FOV: 45 degrees. Color fundus image. 2352x1568 — 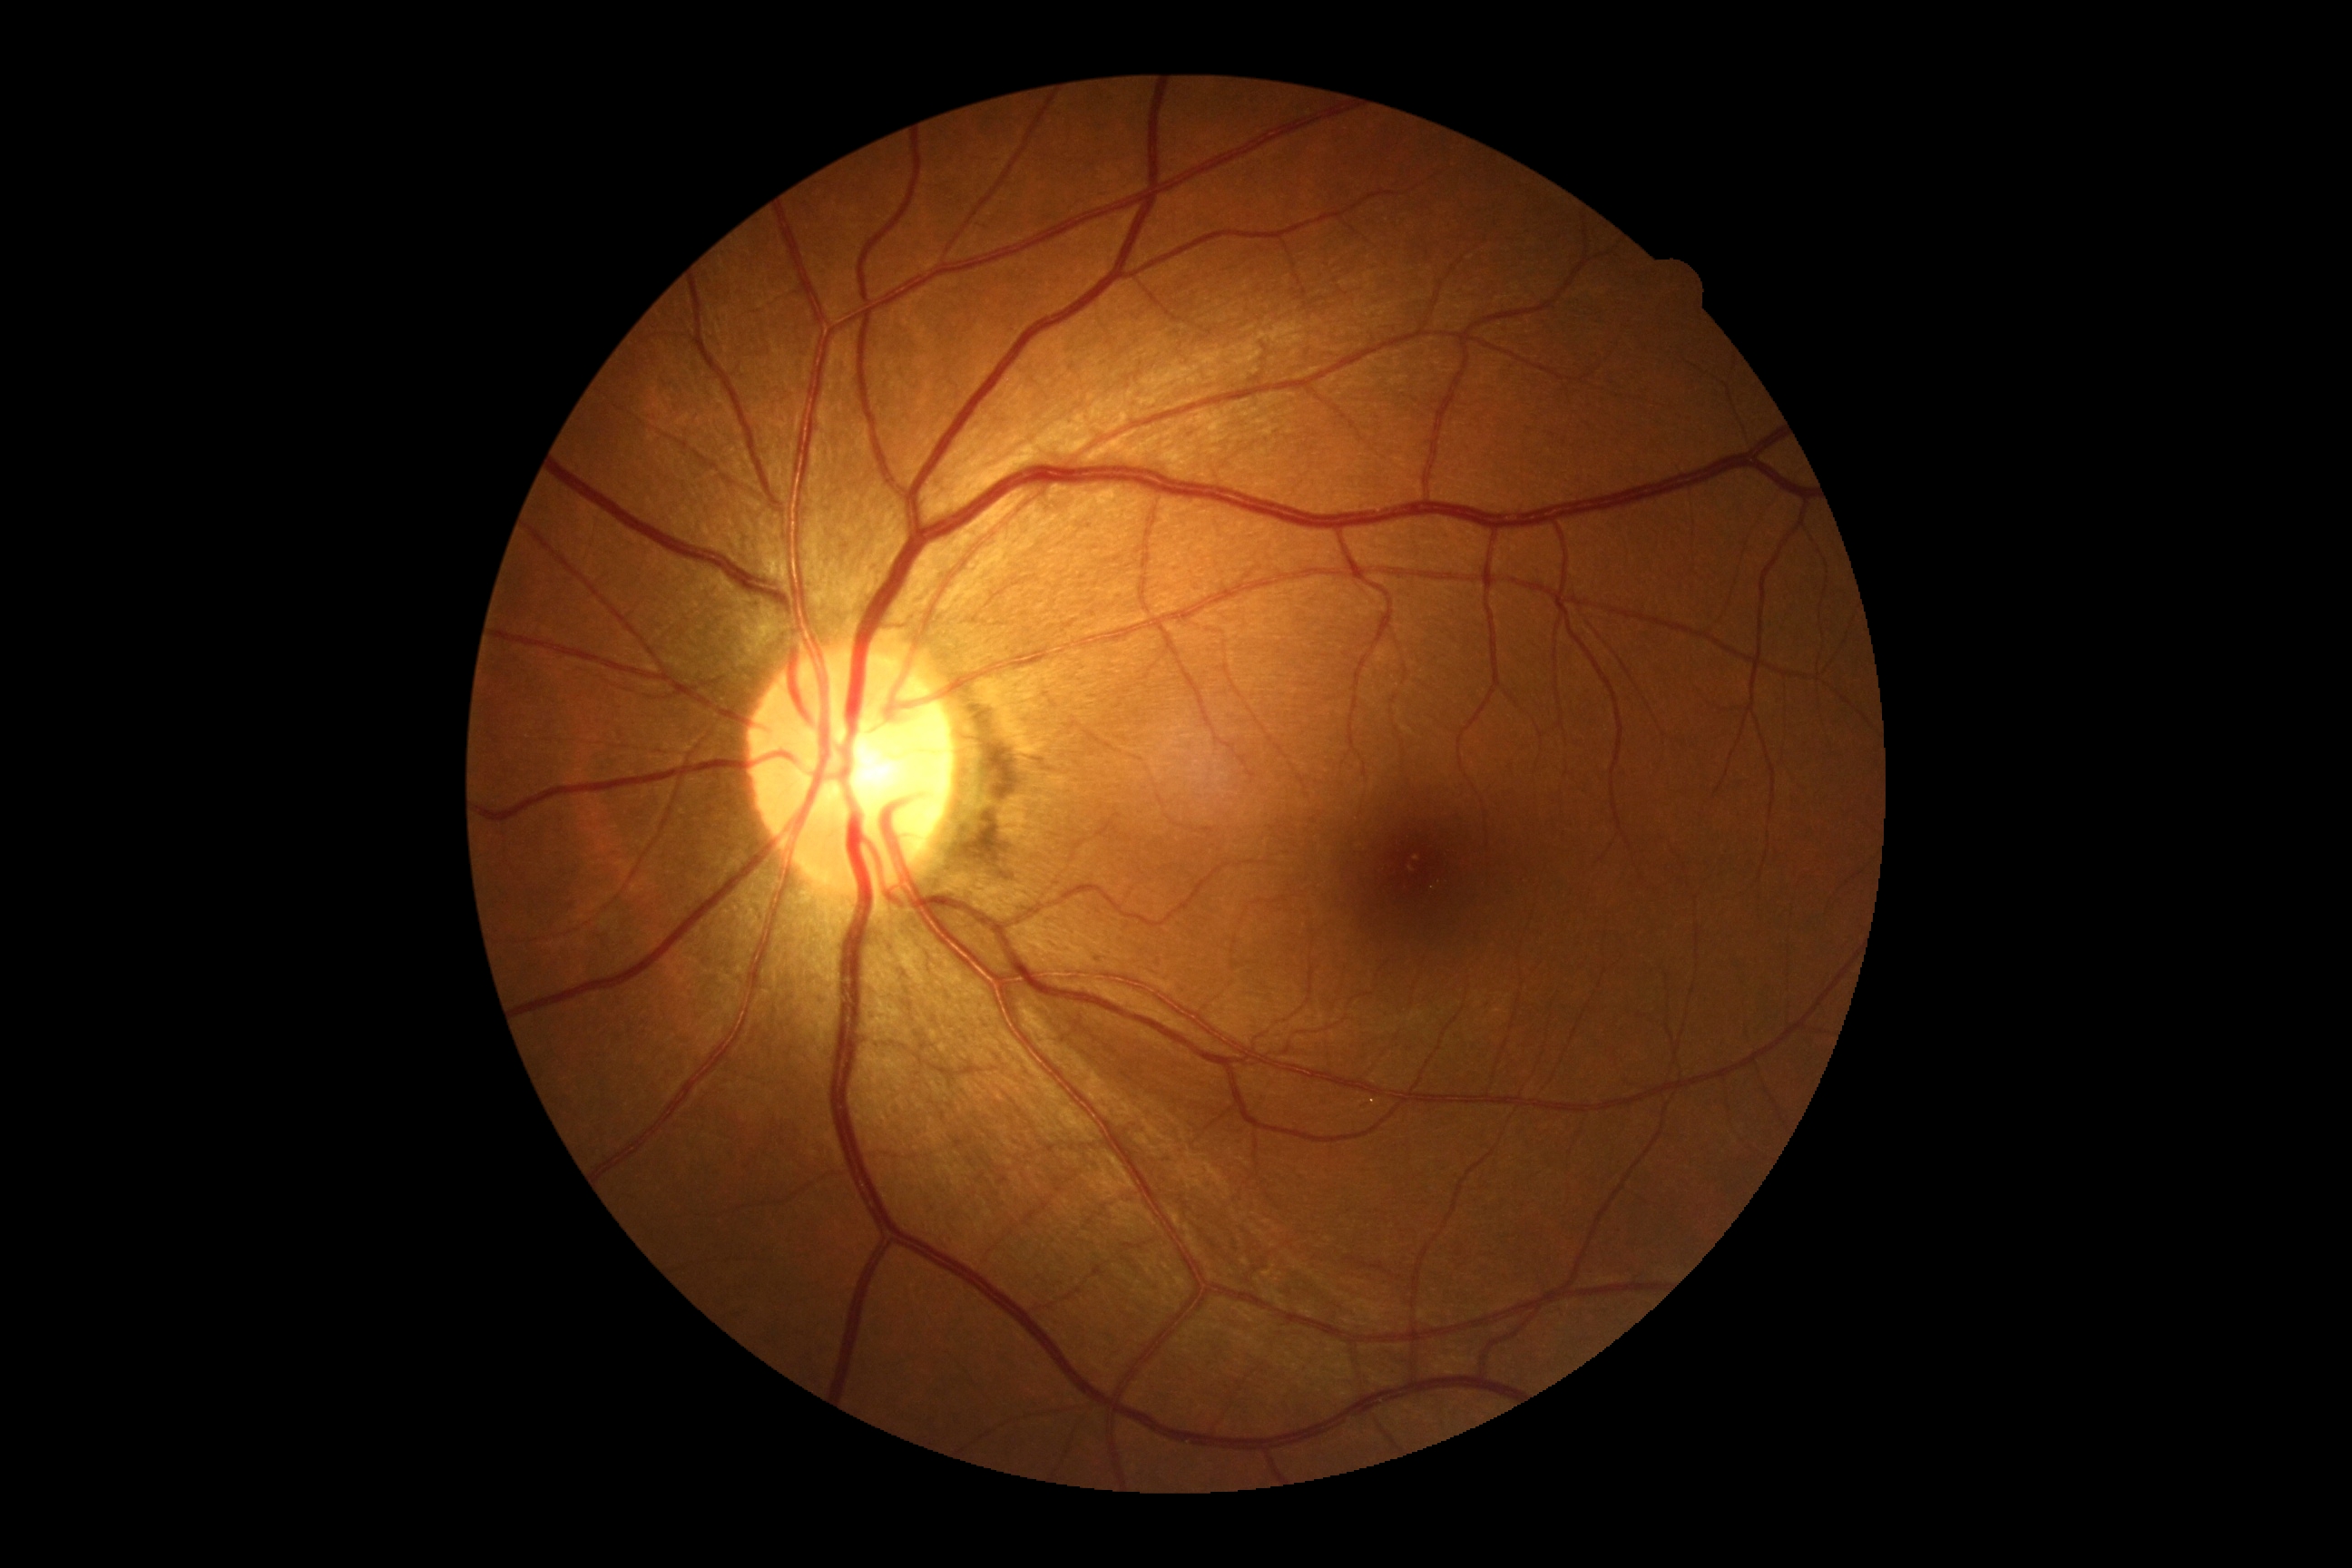
DR severity: grade 0 (no apparent retinopathy).